640 x 480 pixels. RetCam wide-field infant fundus image. 130° field of view (Clarity RetCam 3) — 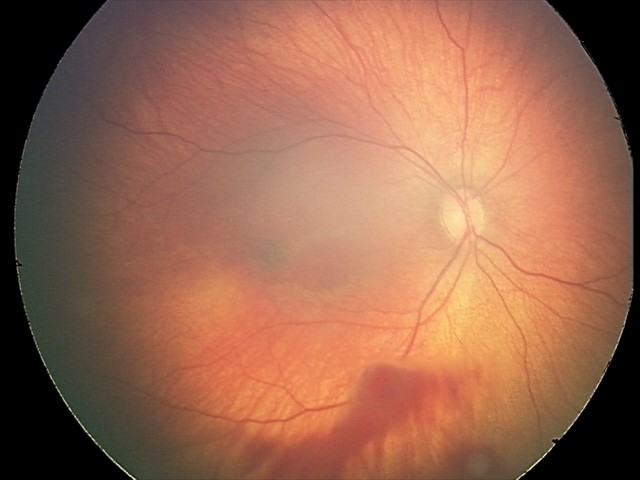 Impression: retinal hemorrhages.